Image size 2048x1536:
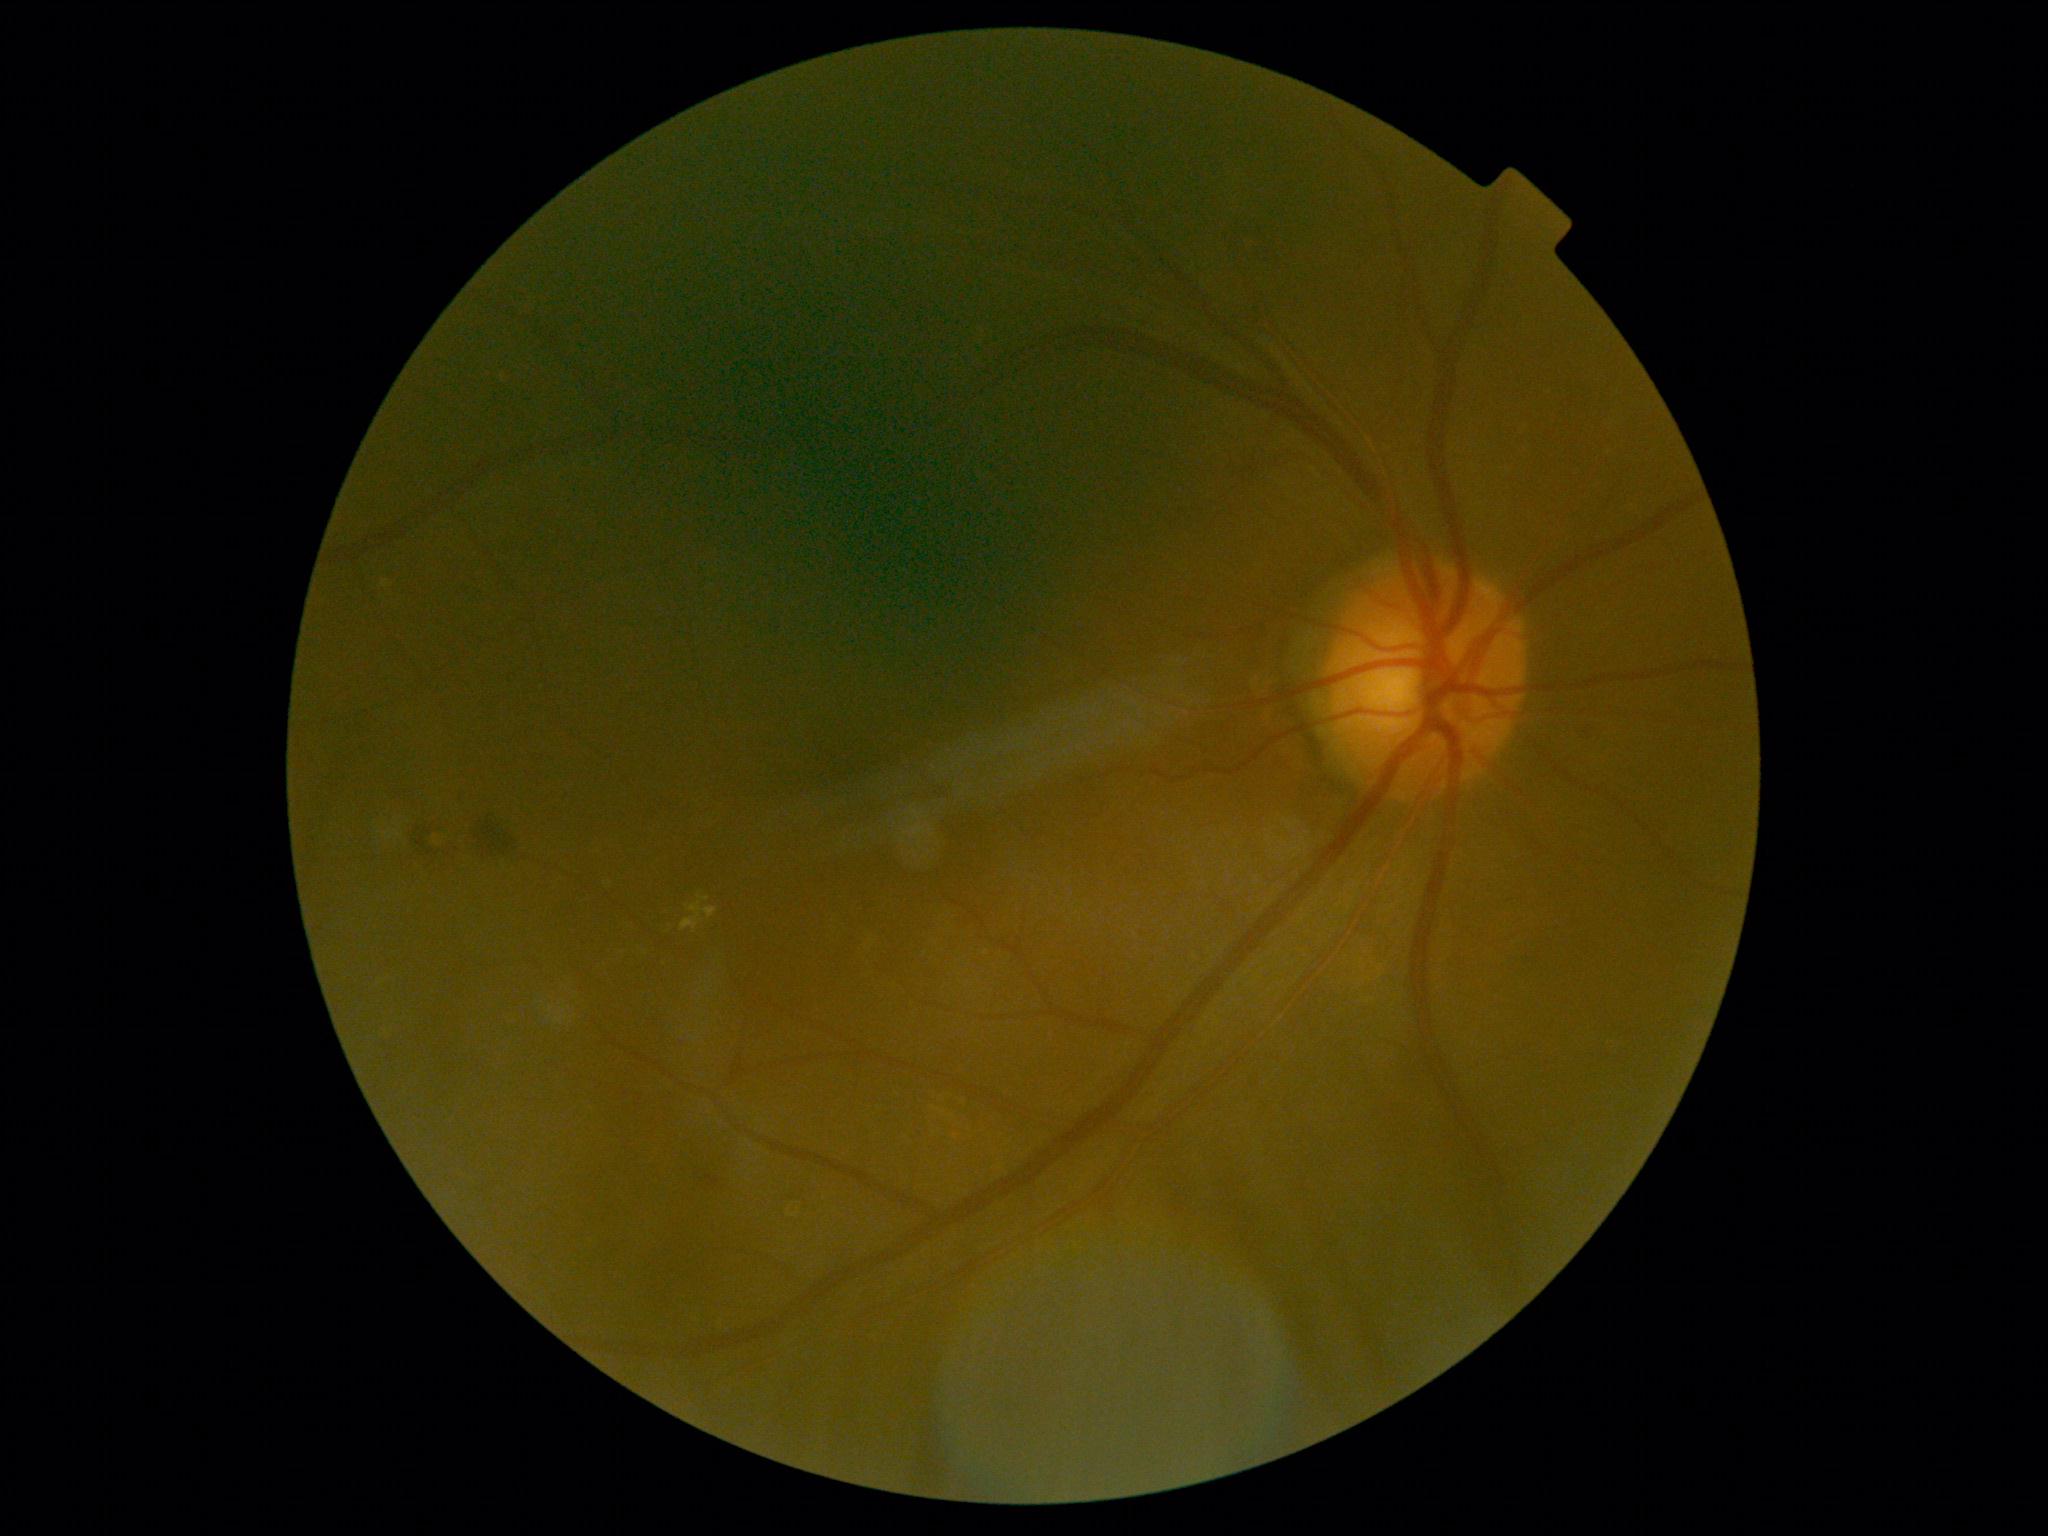

diabetic retinopathy (DR)=grade 2.